No pharmacologic dilation · NIDEK AFC-230 fundus camera: 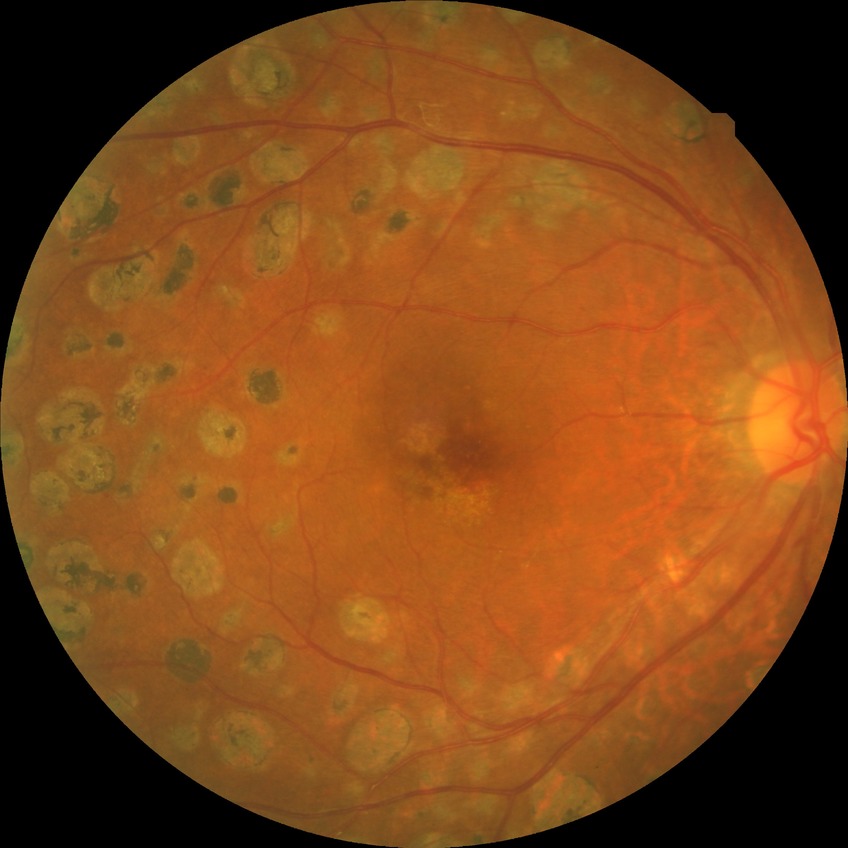
DR severity: PDR.